Dilated-pupil acquisition · color fundus photograph:
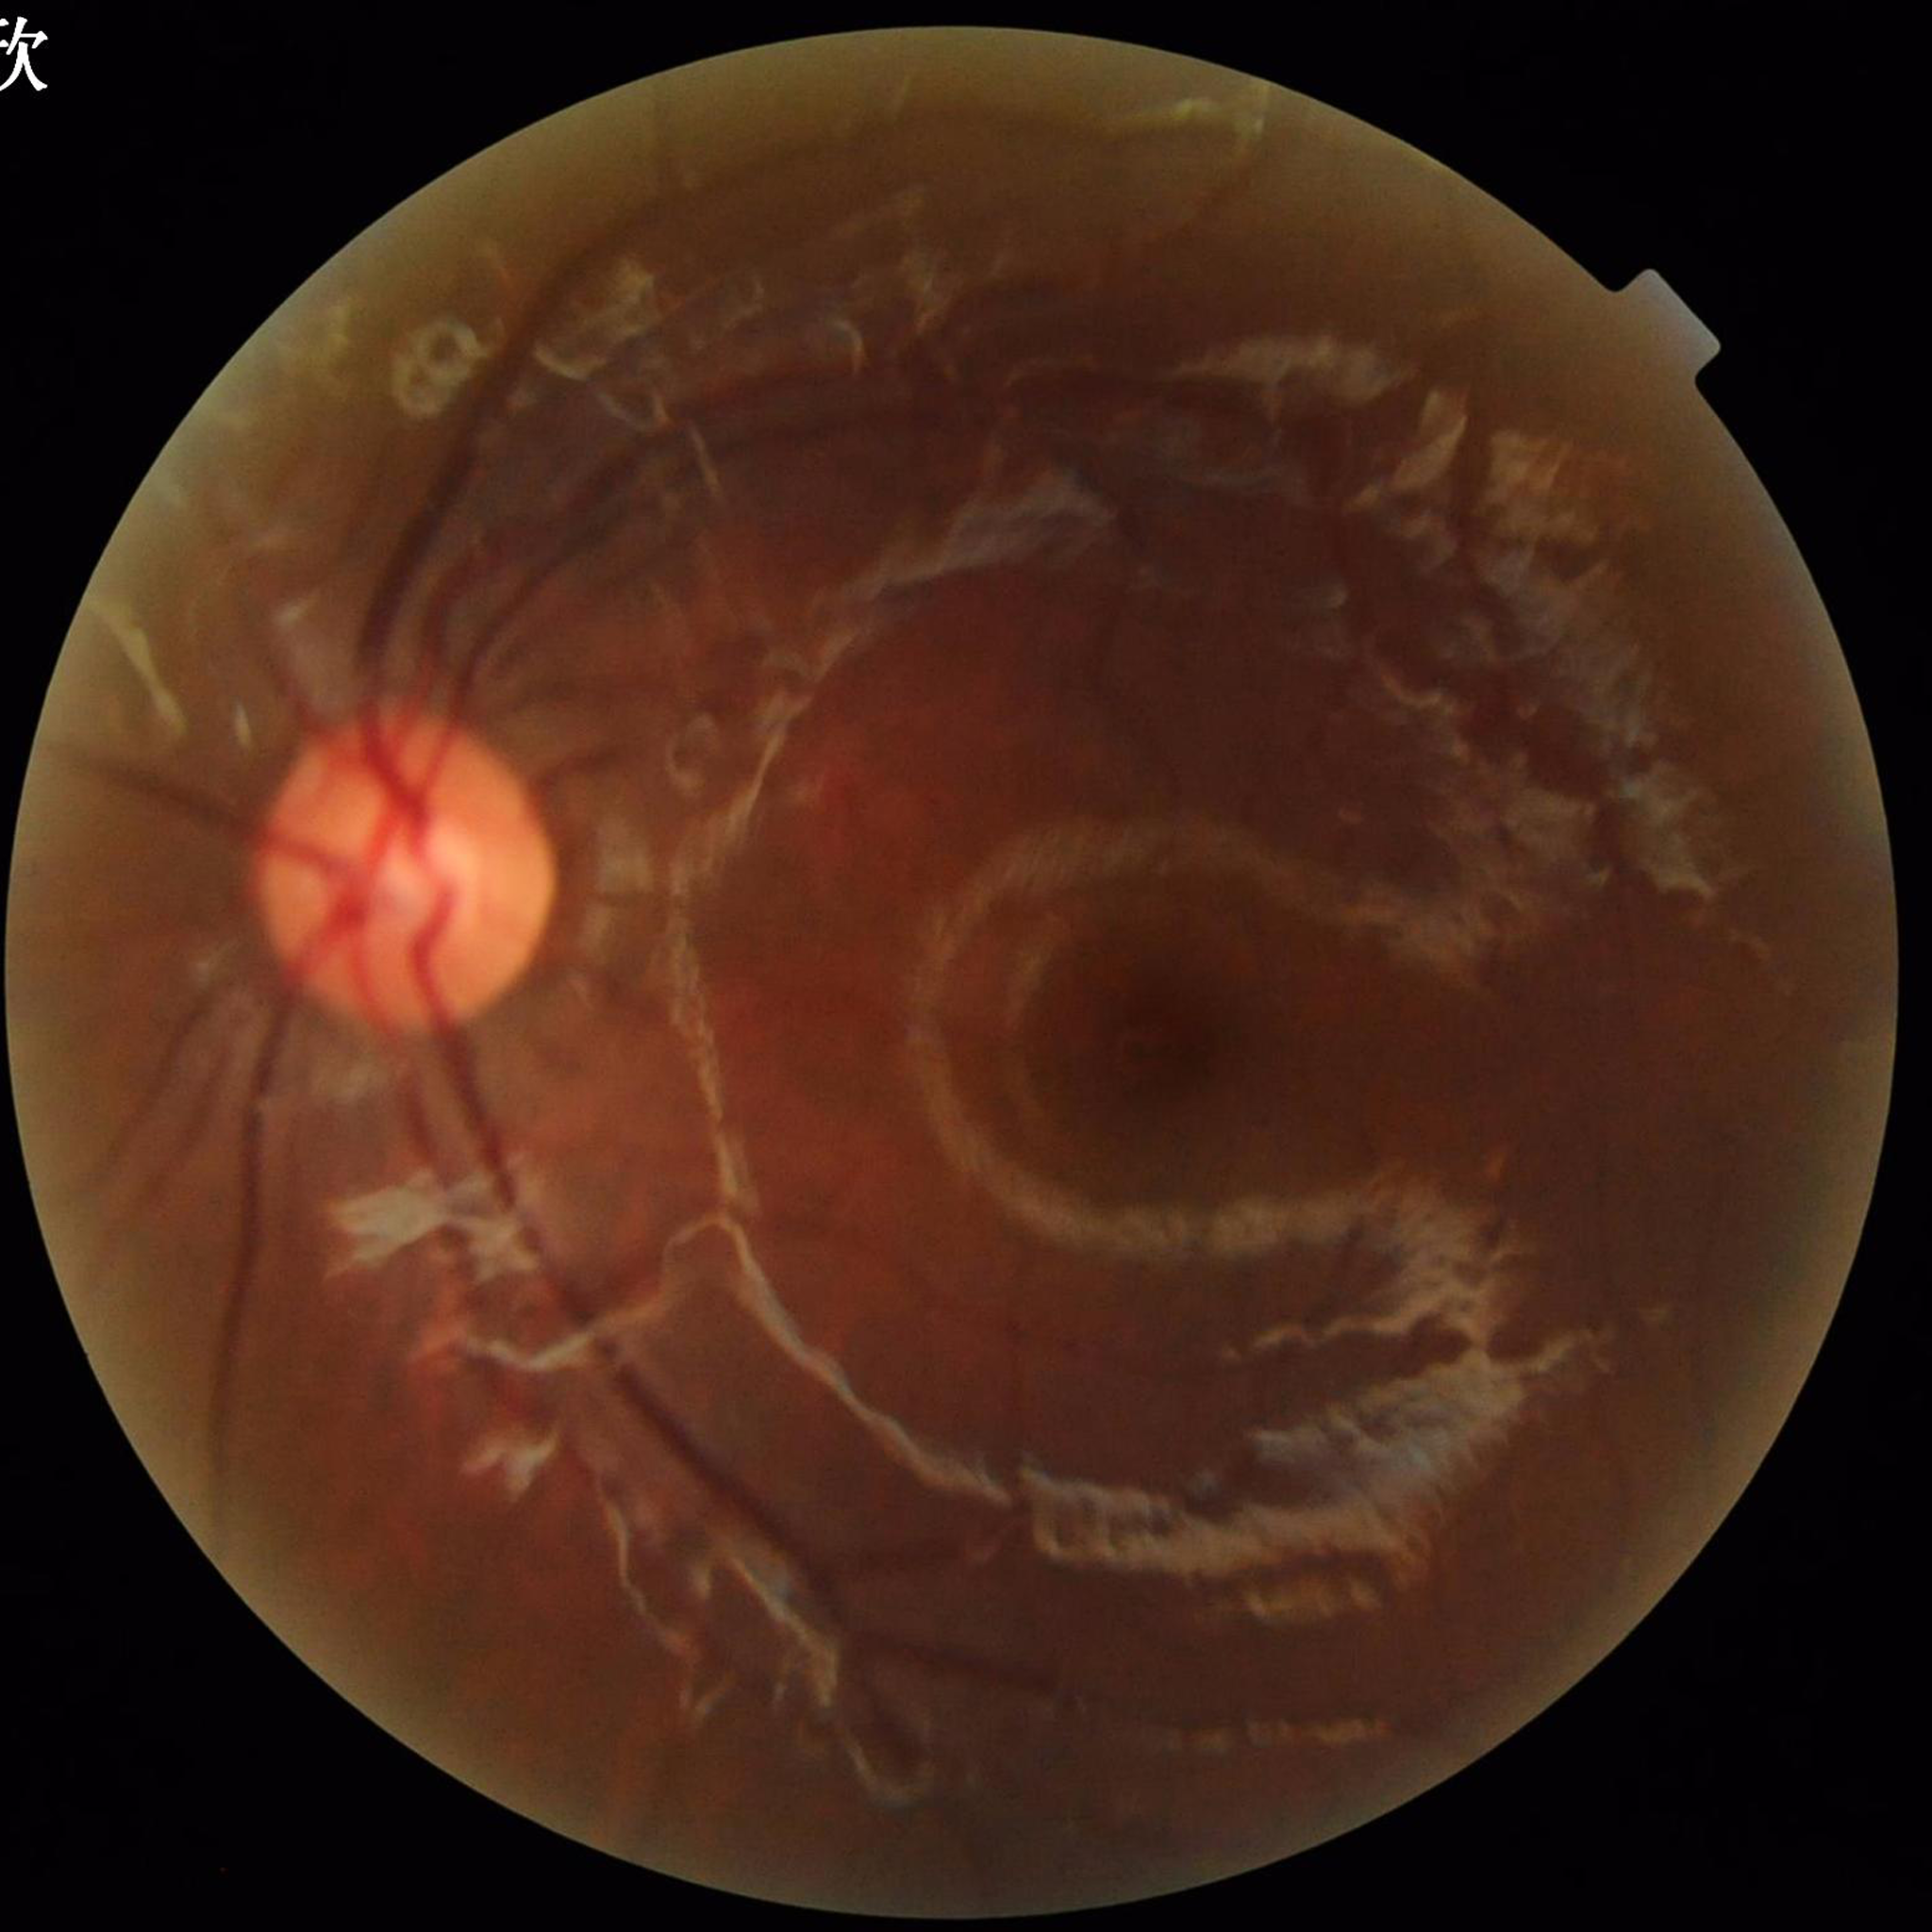

Impression = no AMD, DR, or glaucoma; Quality assessment = poor — blur, illumination/color distortion.